Wide-field fundus image from infant ROP screening · Phoenix ICON, 100° FOV:
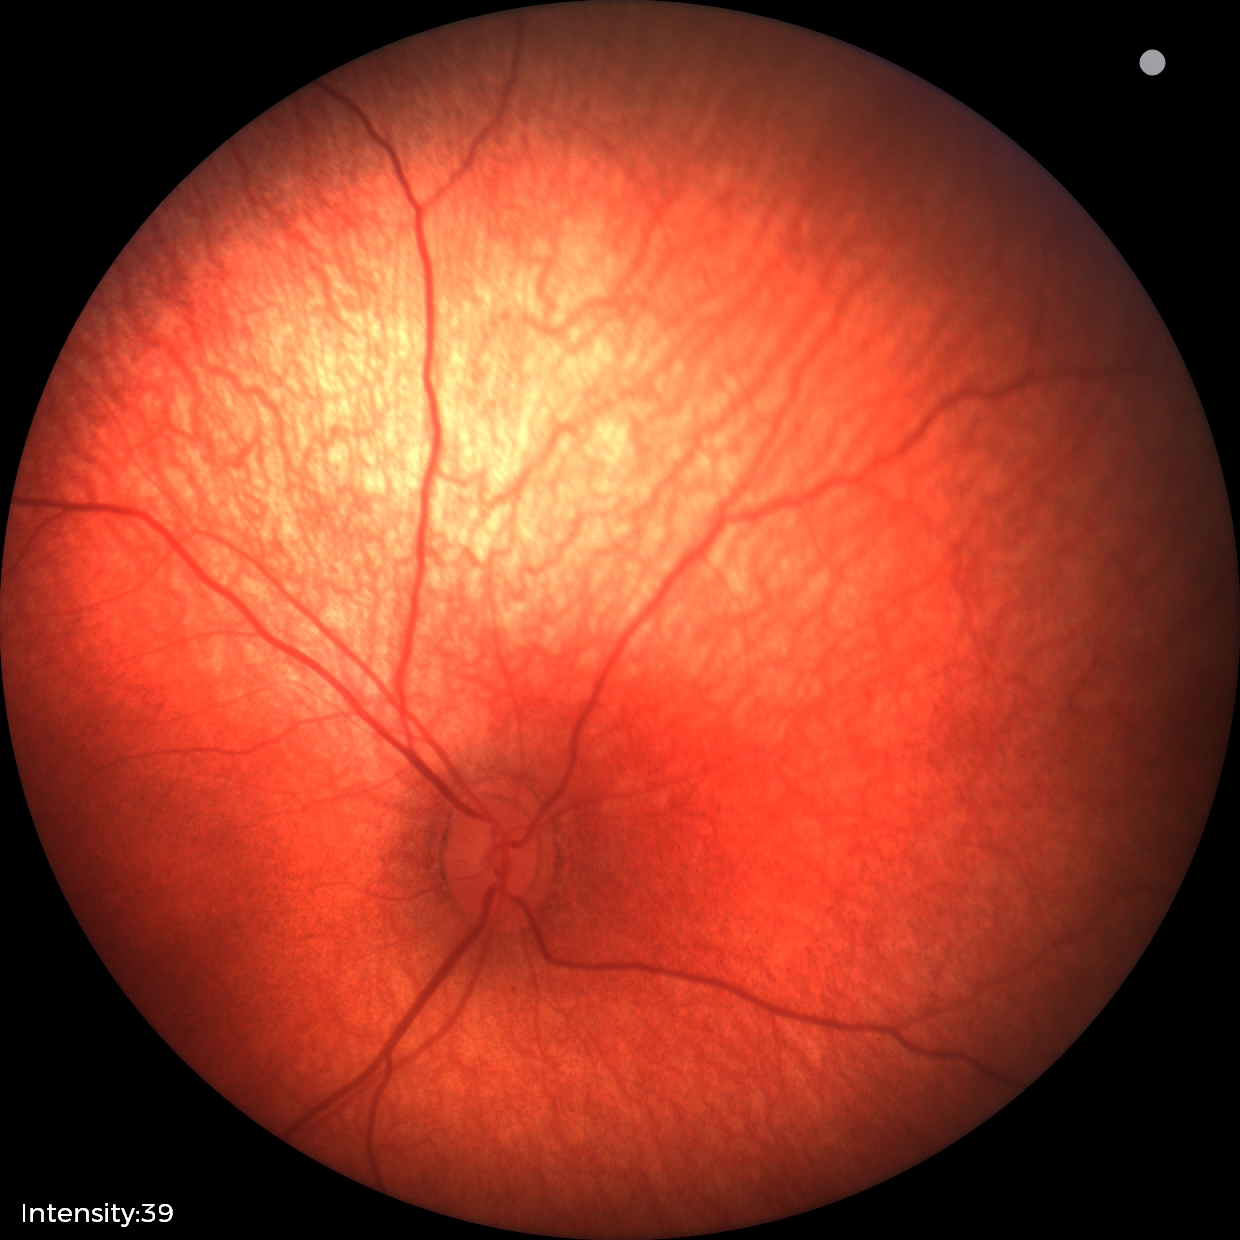
Screening examination with no abnormal retinal findings.